Davis DR grading — 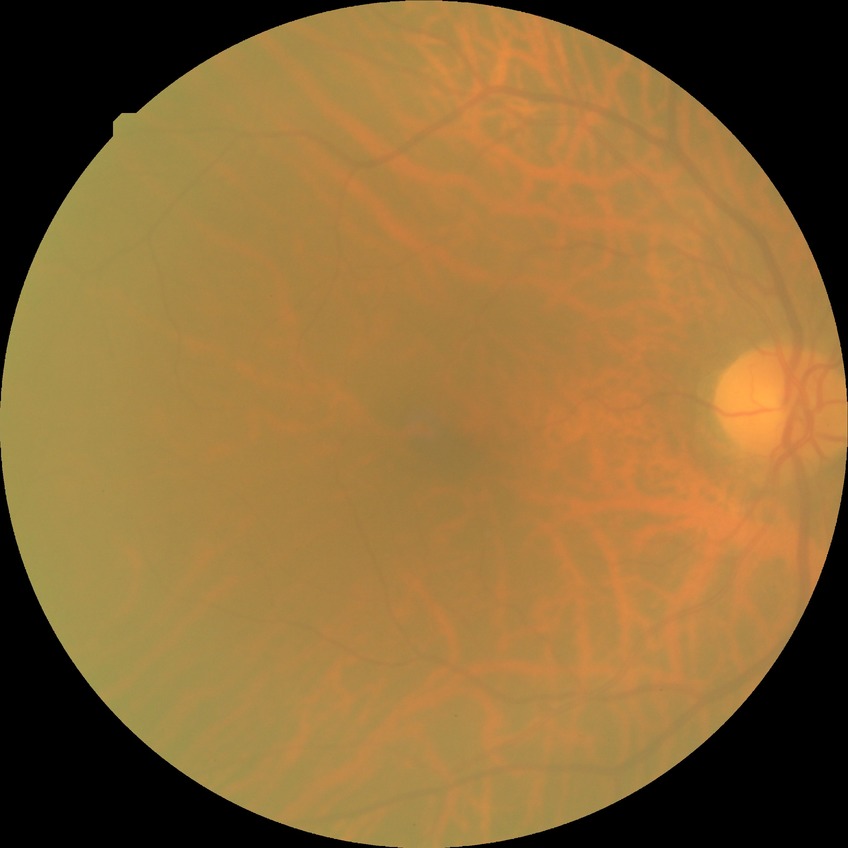
Diabetic retinopathy stage: no diabetic retinopathy.